Graded on the modified Davis scale · nonmydriatic fundus photograph · image size 848x848.
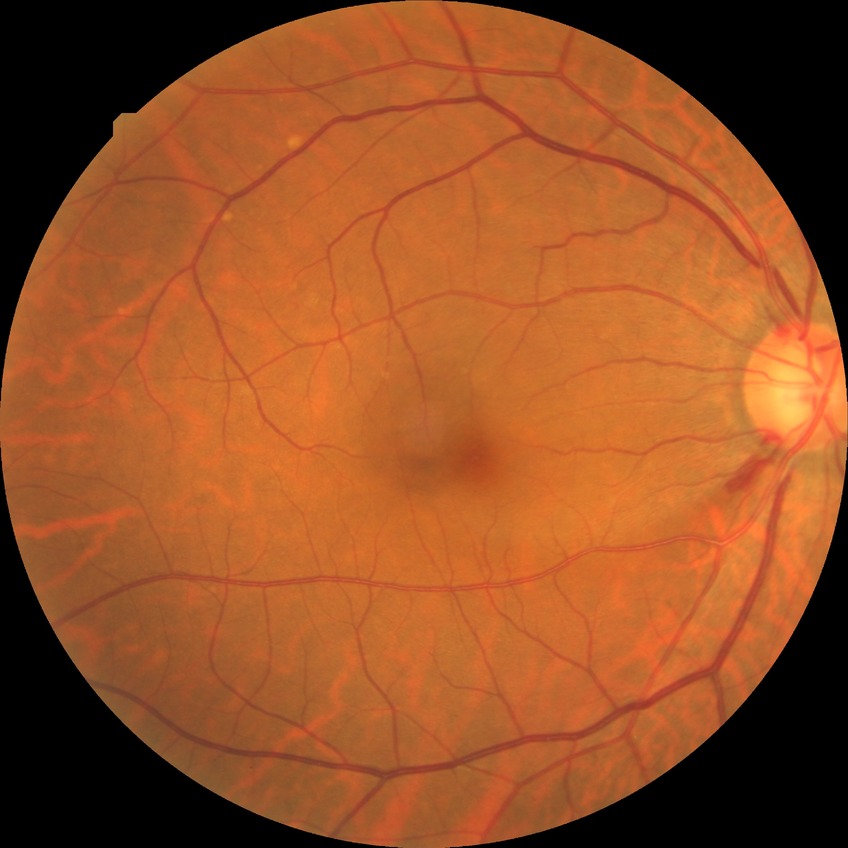 Modified Davis grading: no diabetic retinopathy.